No pharmacologic dilation; 45-degree field of view; posterior pole photograph.
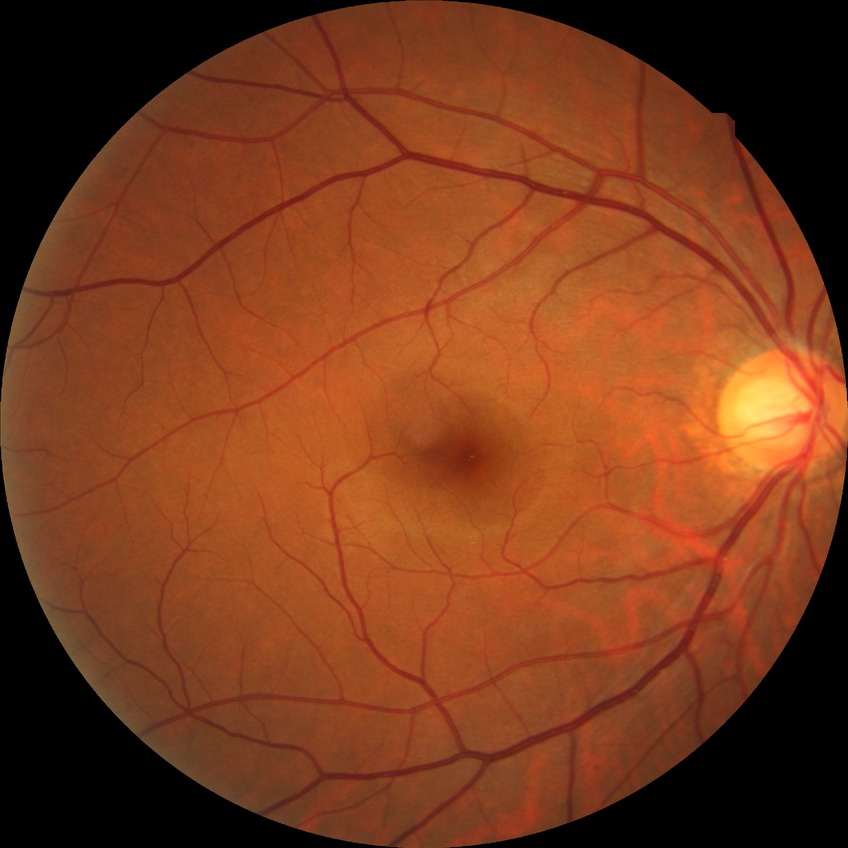 Diabetic retinopathy (DR) is NDR (no diabetic retinopathy).